Fundus photo. FOV: 45 degrees. 1932 x 1910 pixels — 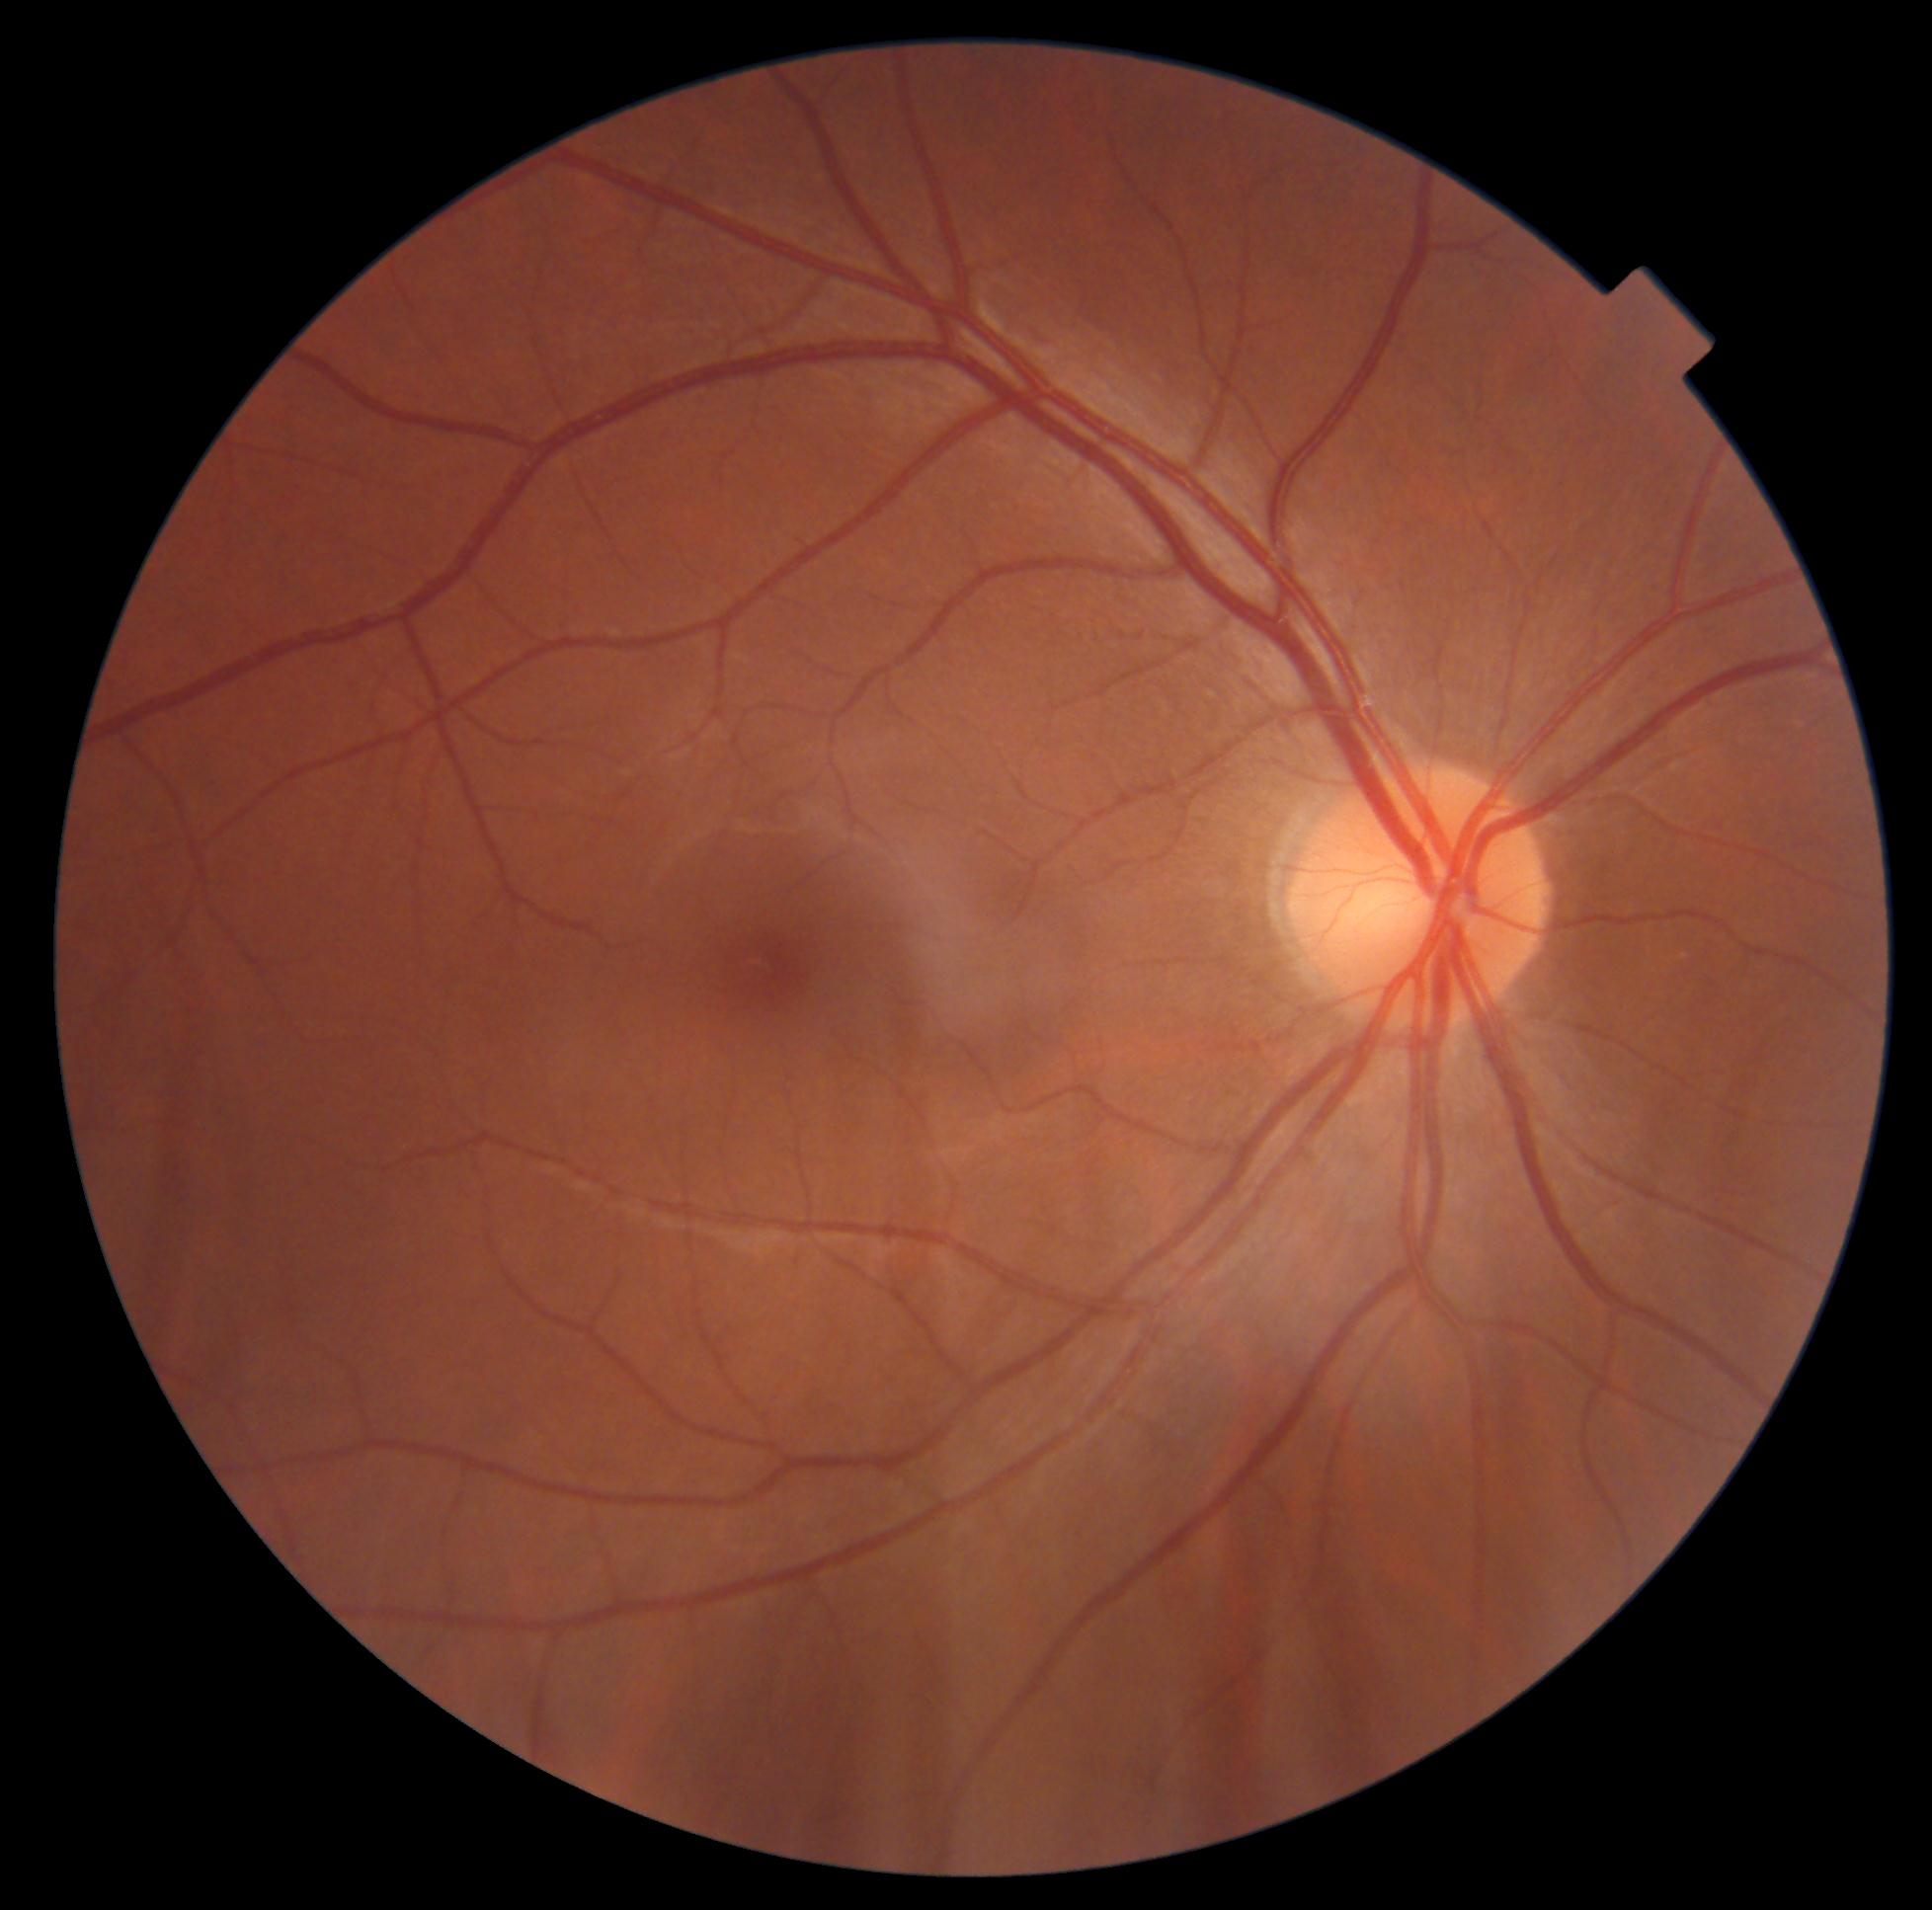
DR impression=no apparent DR; diabetic retinopathy severity=grade 0 (no apparent retinopathy).